Wide-field fundus photograph of an infant. Camera: Clarity RetCam 3 (130° FOV). Image size 640x480
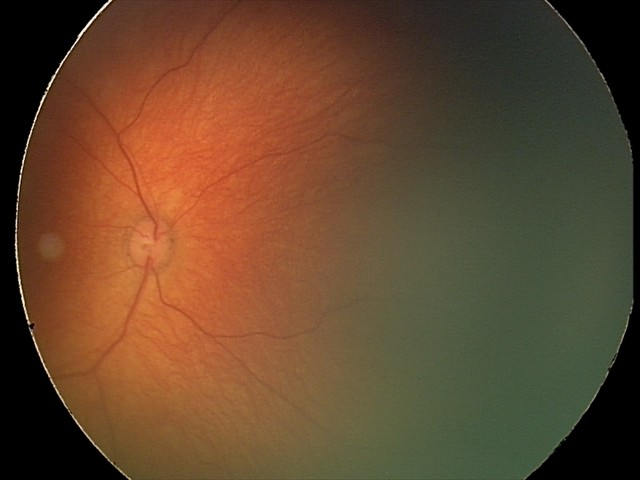 Screening examination with no abnormal retinal findings.